Image size 1974x1483:
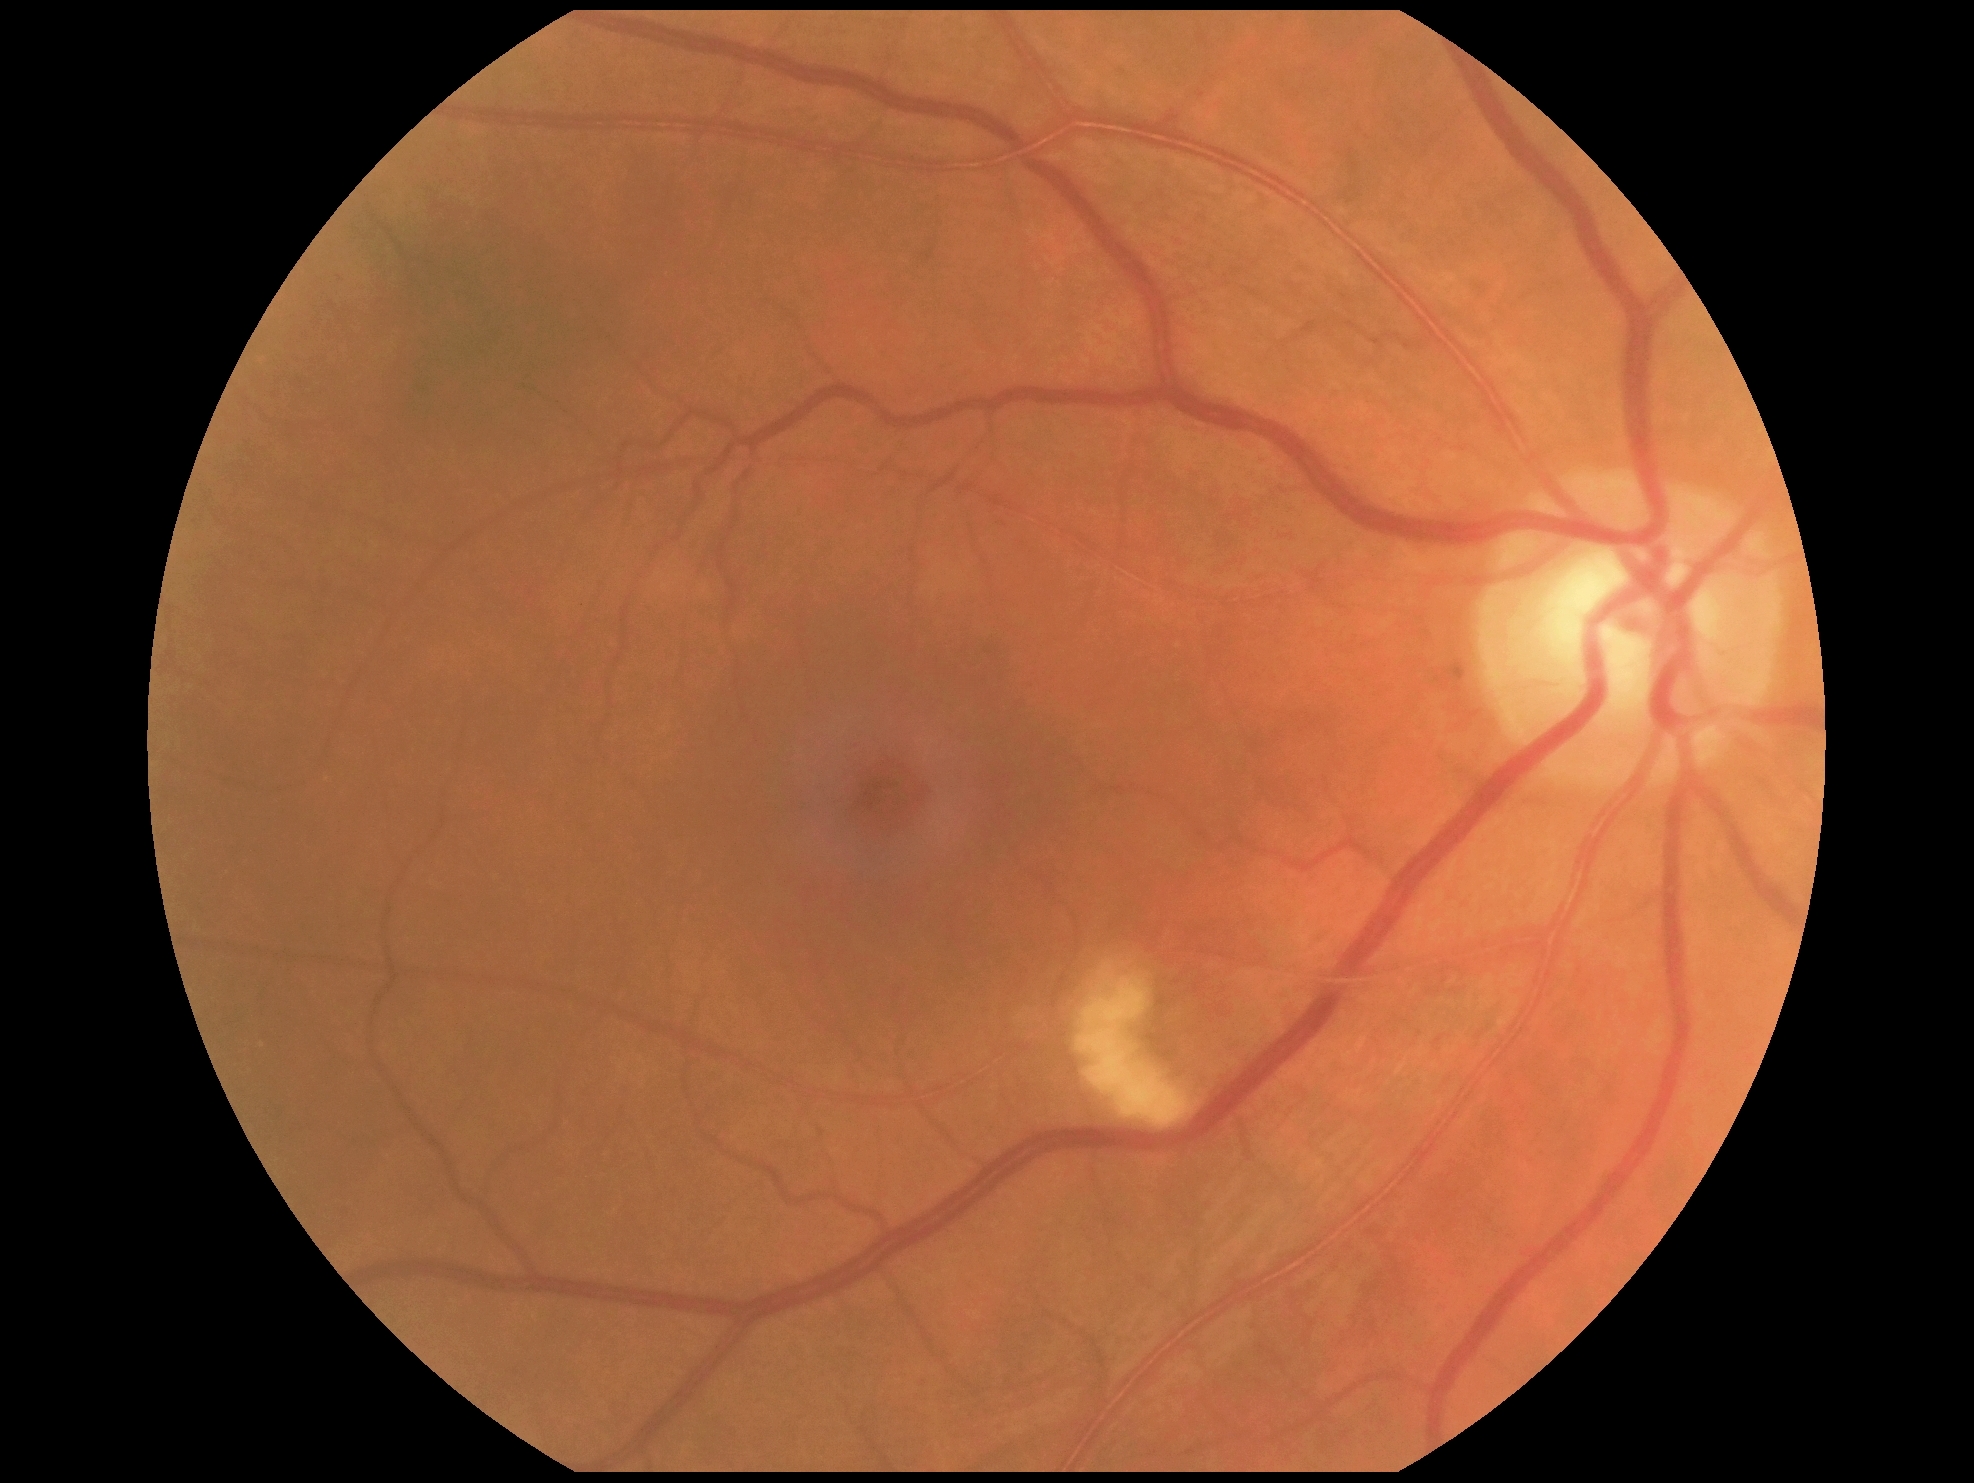 DR class: non-proliferative diabetic retinopathy | DR severity: moderate NPDR (grade 2) — more than just microaneurysms but less than severe NPDR.